Wide-field fundus photograph of an infant · camera: Phoenix ICON (100° FOV): 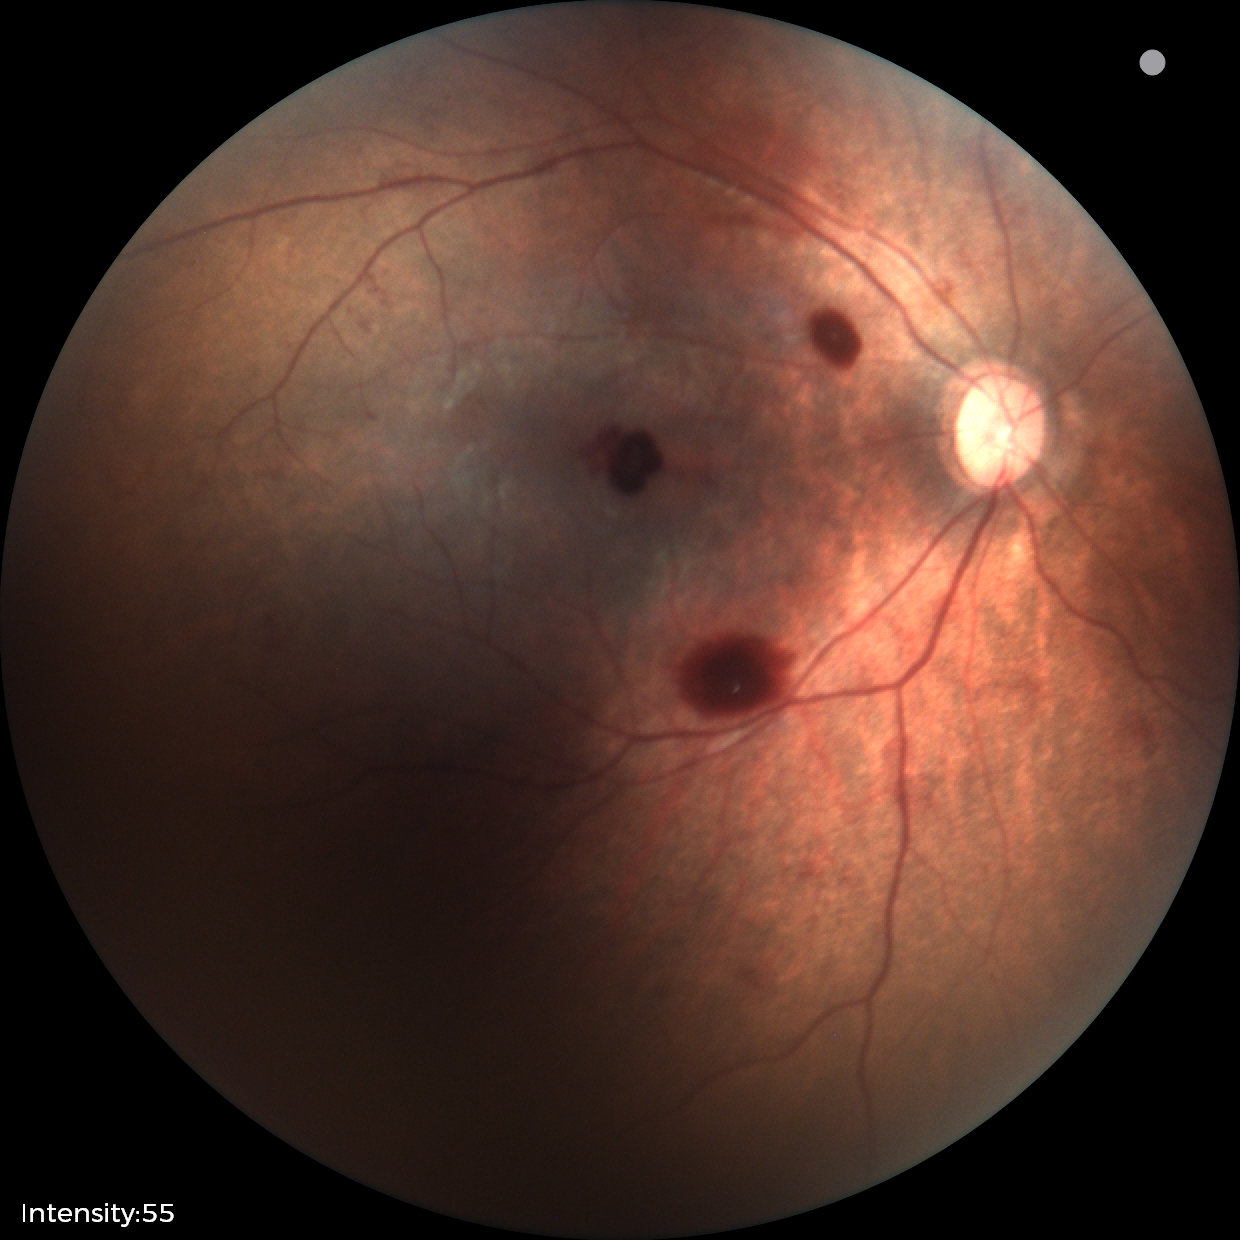

Screening diagnosis: retinal hemorrhages.